130° field of view (Clarity RetCam 3); infant wide-field fundus photograph:
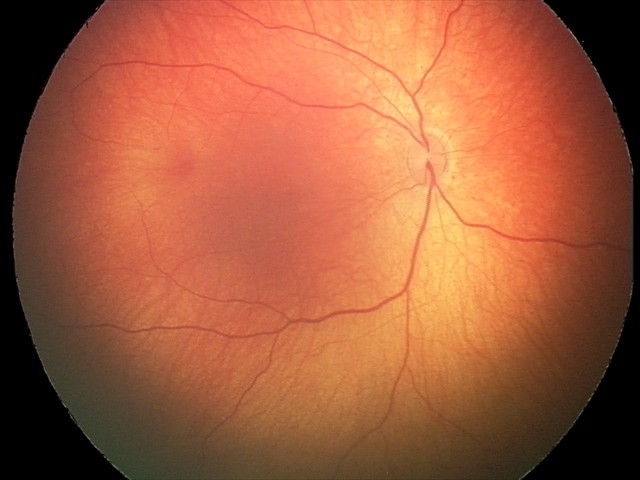

Screening series with retinal hemorrhages.